Infant wide-field fundus photograph · 1240x1240 · acquired on the Phoenix ICON — 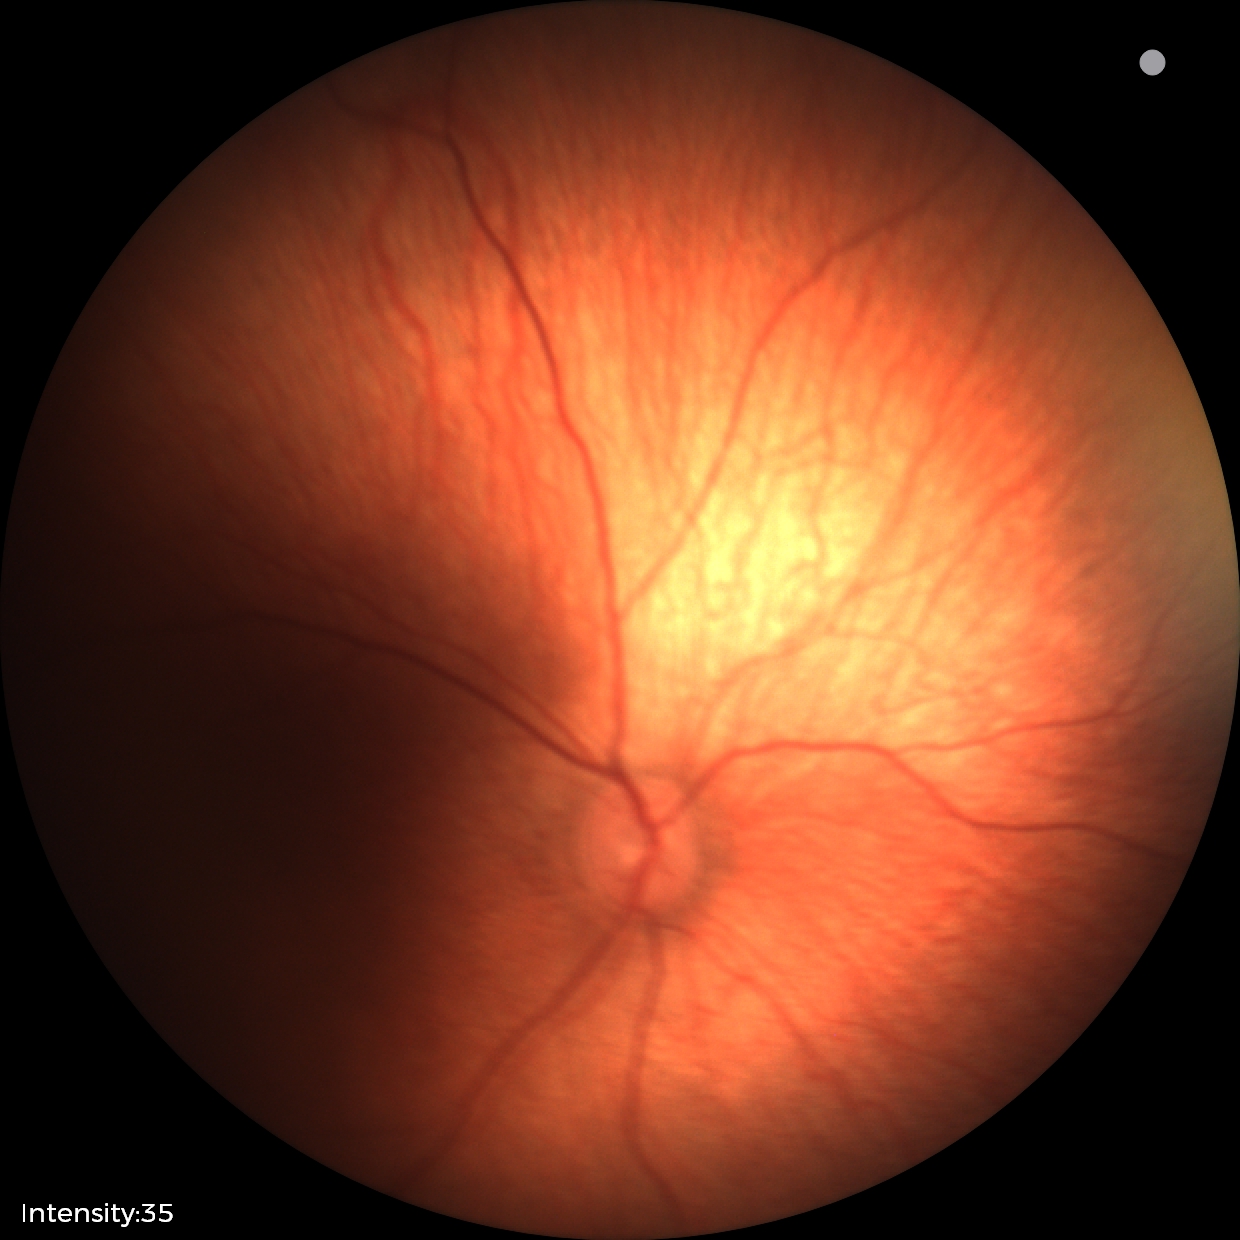
Screening examination with no abnormal retinal findings.